Ultra-widefield fundus mosaic, 200° field of view, 1924 by 1556 pixels — 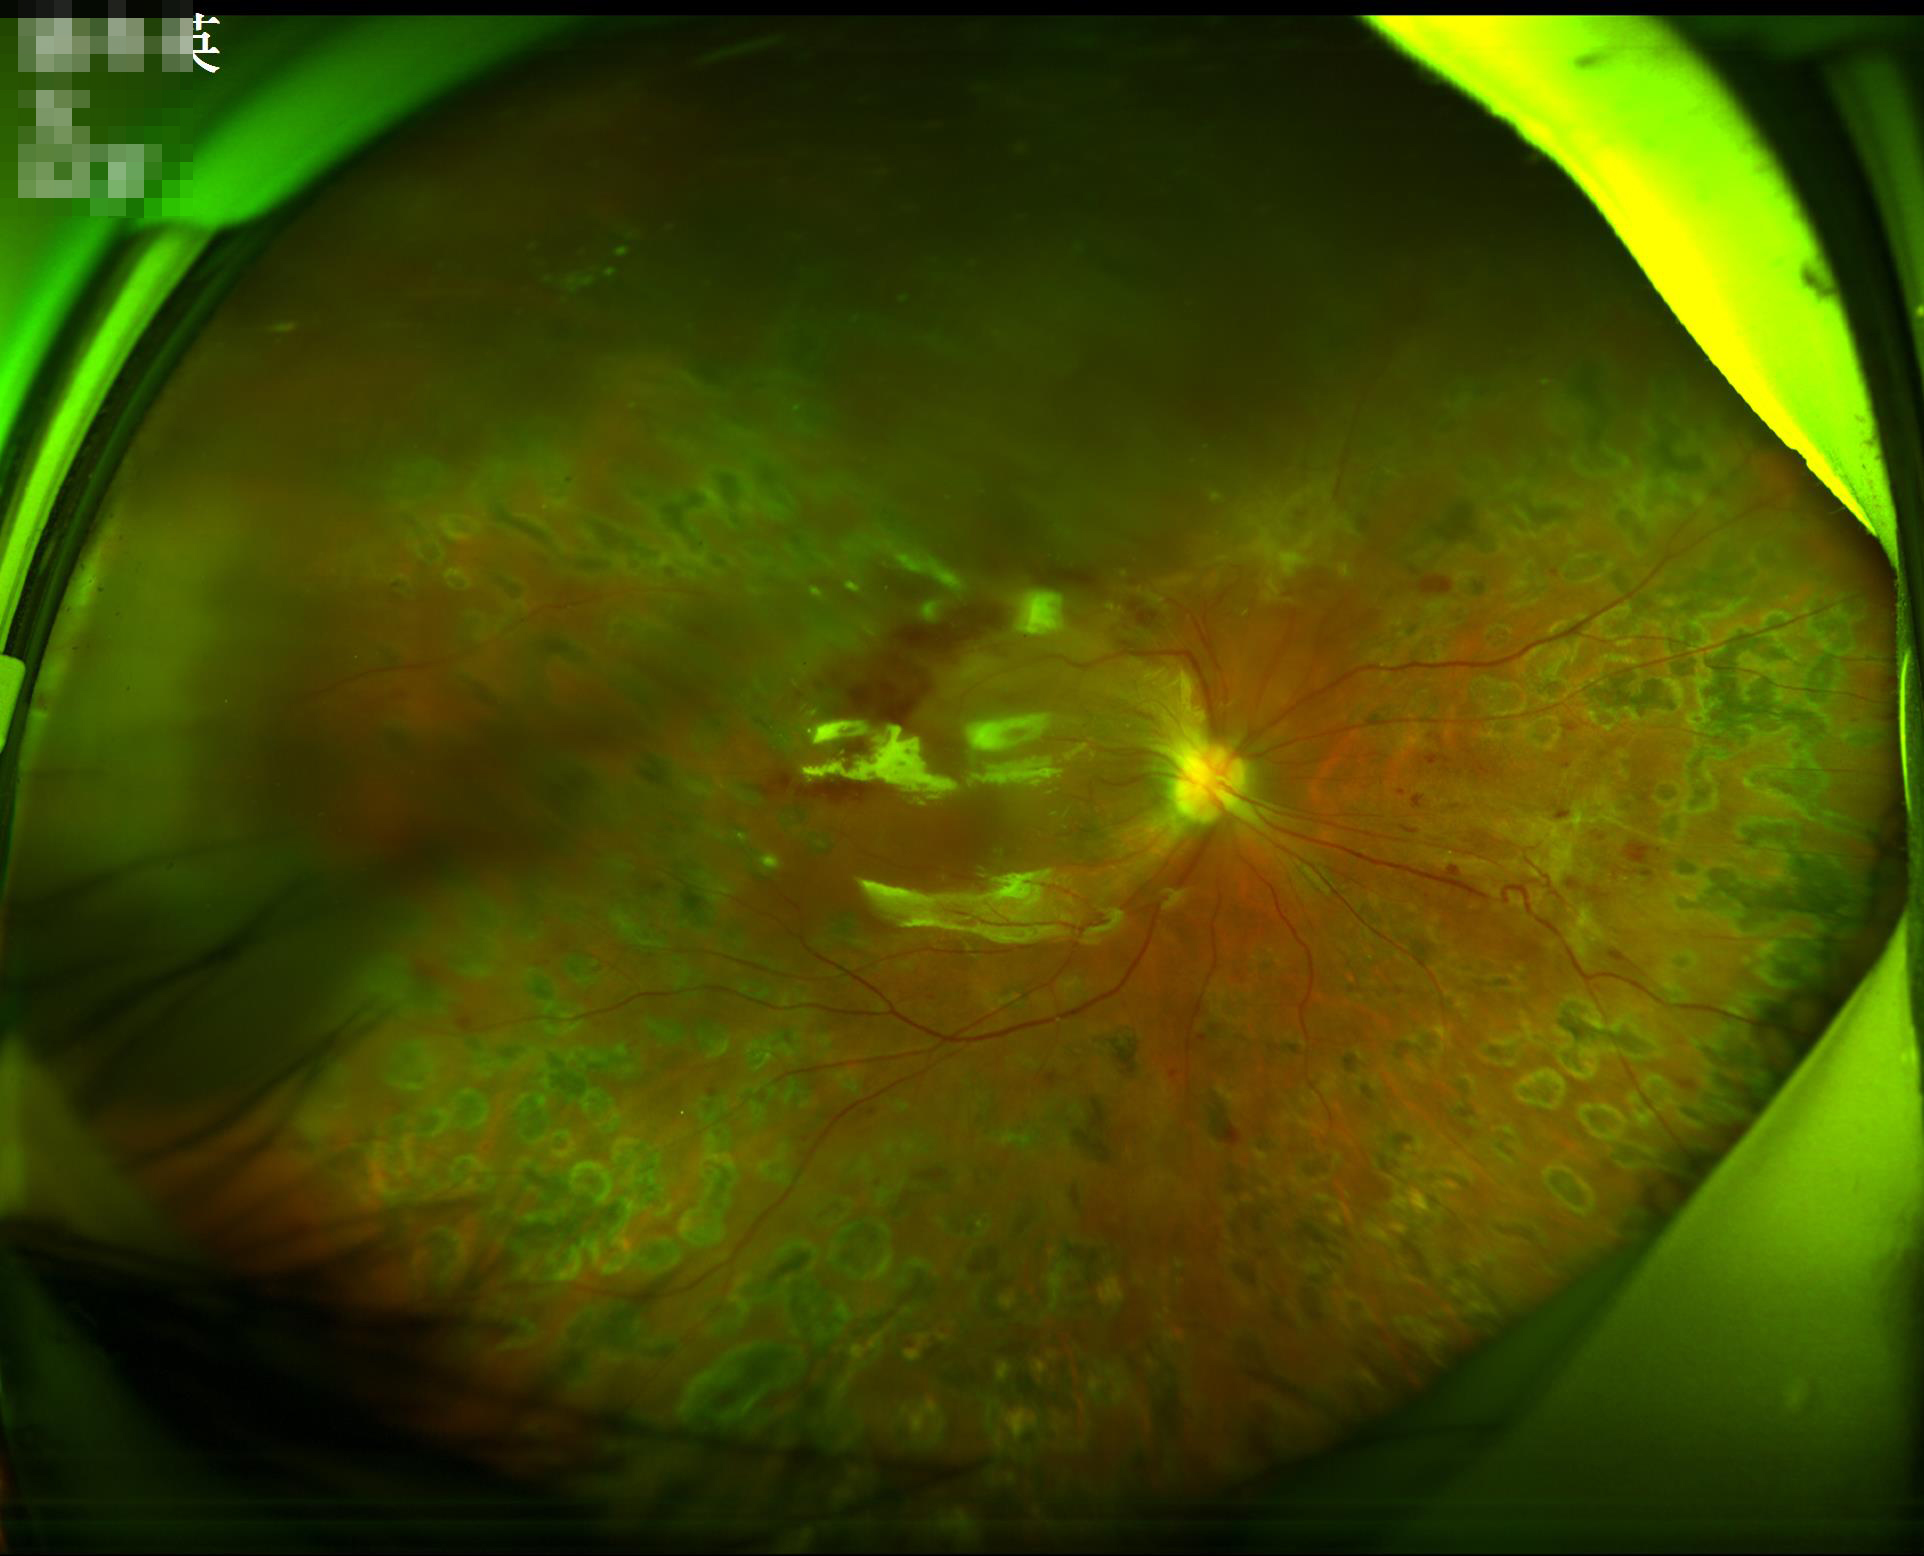

Quality assessment: focus: in focus | illumination/color: good | overall: suboptimal.